Image size 2048x1536: 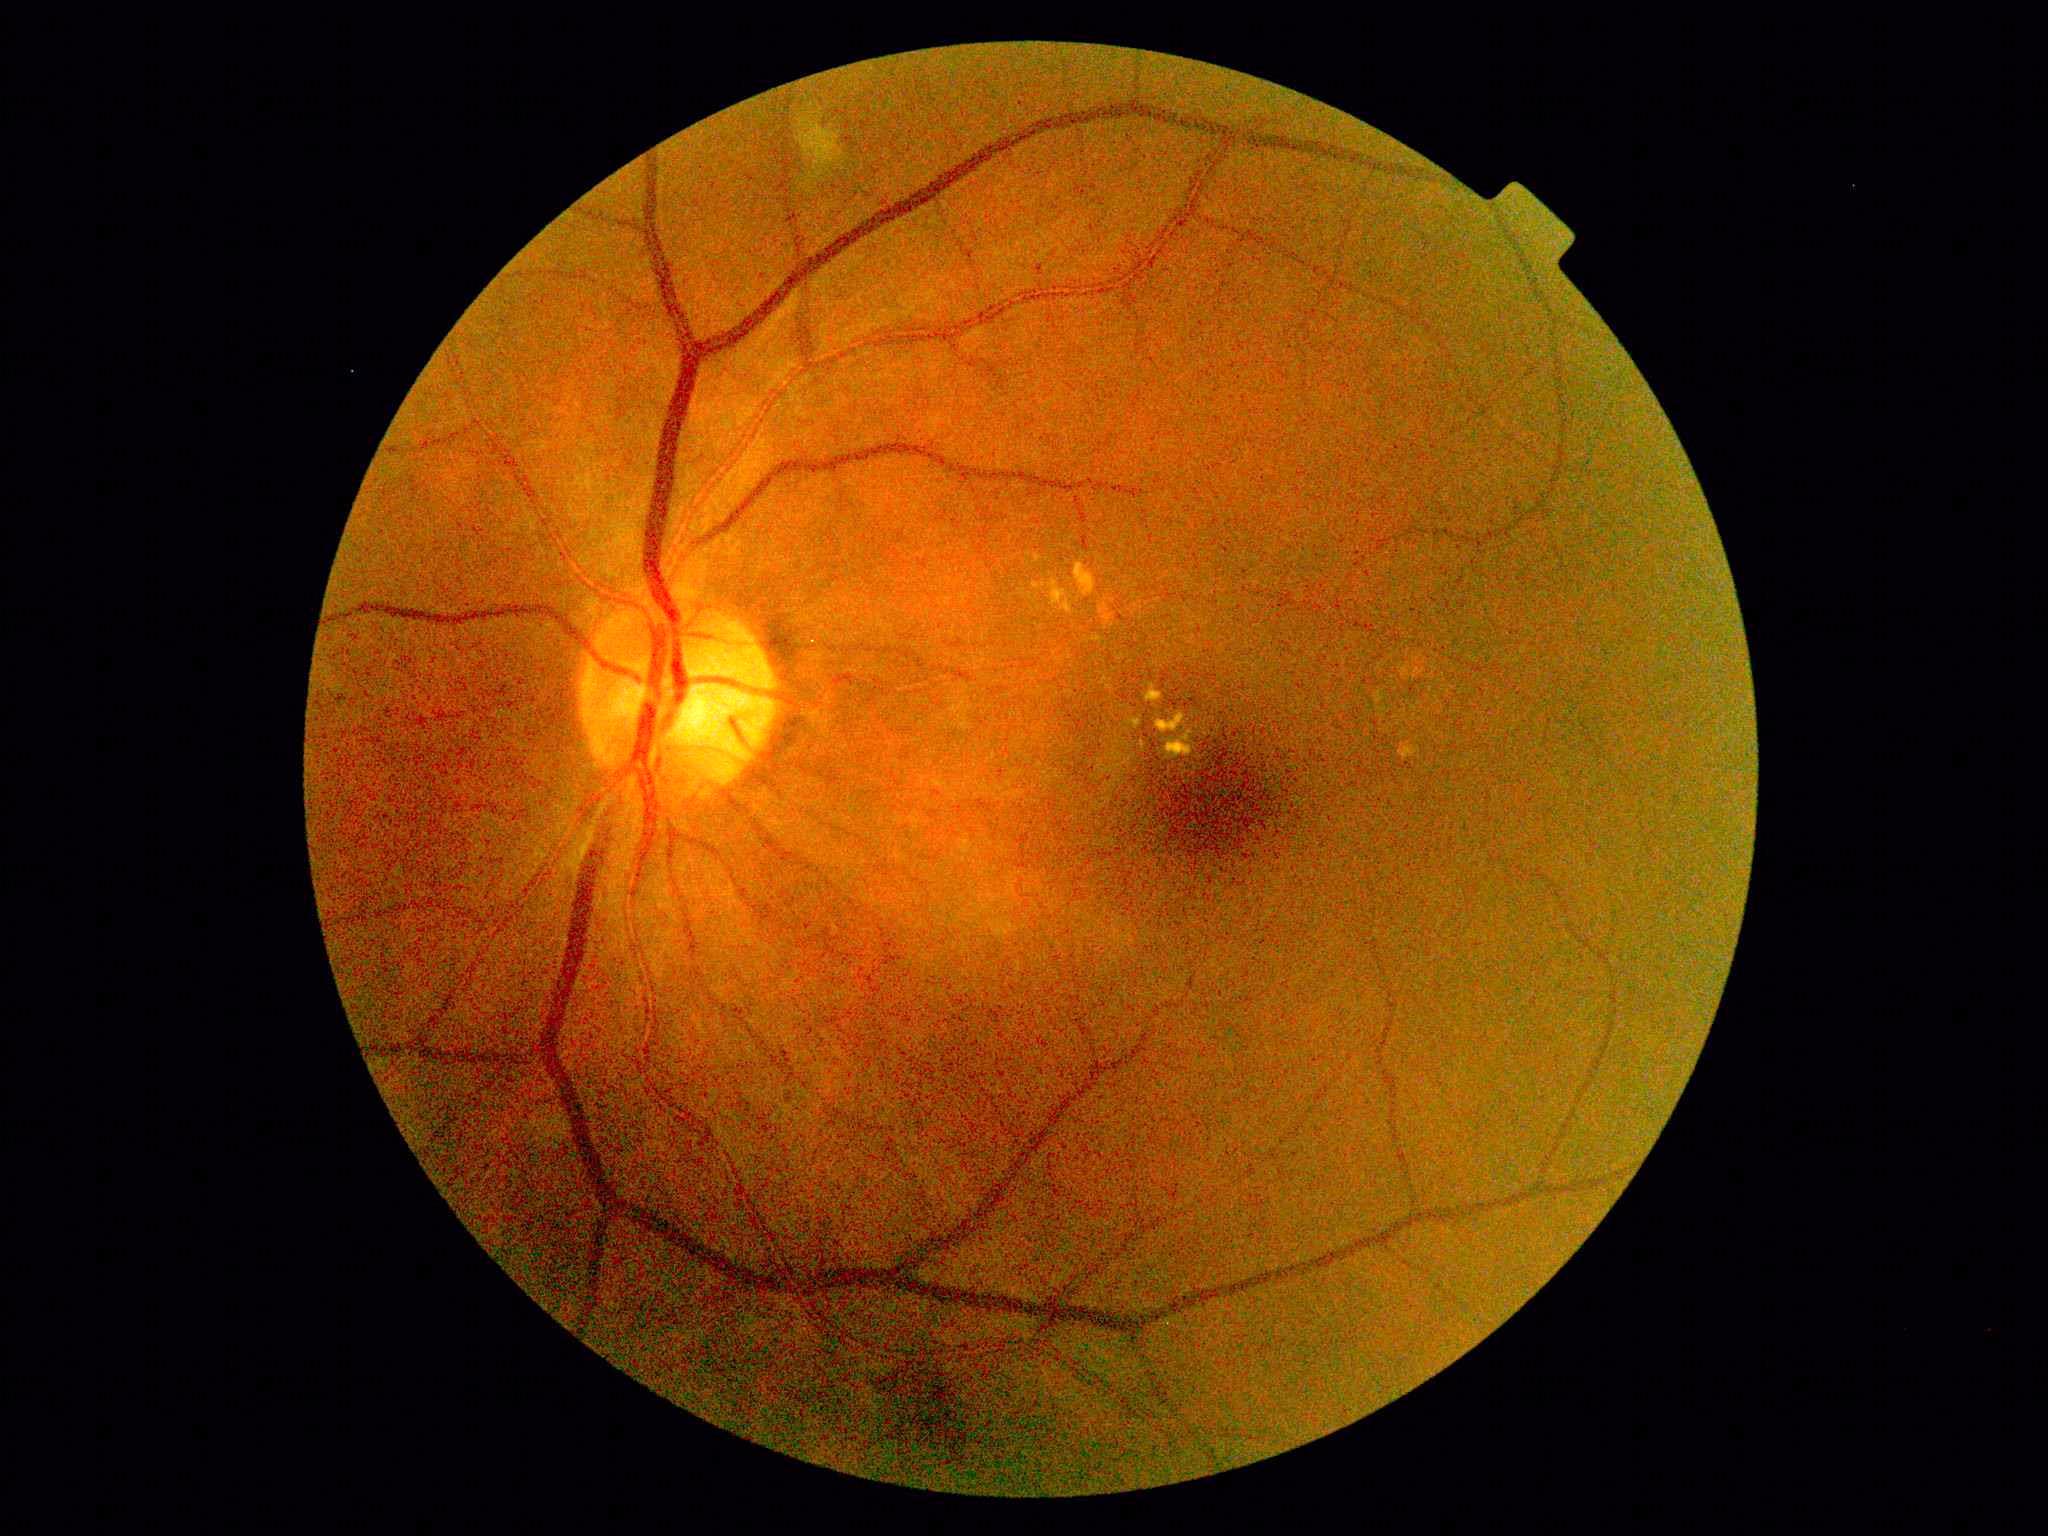
– DR — moderate NPDR (grade 2)